Diabetic retinopathy graded by the modified Davis classification · 45-degree field of view — 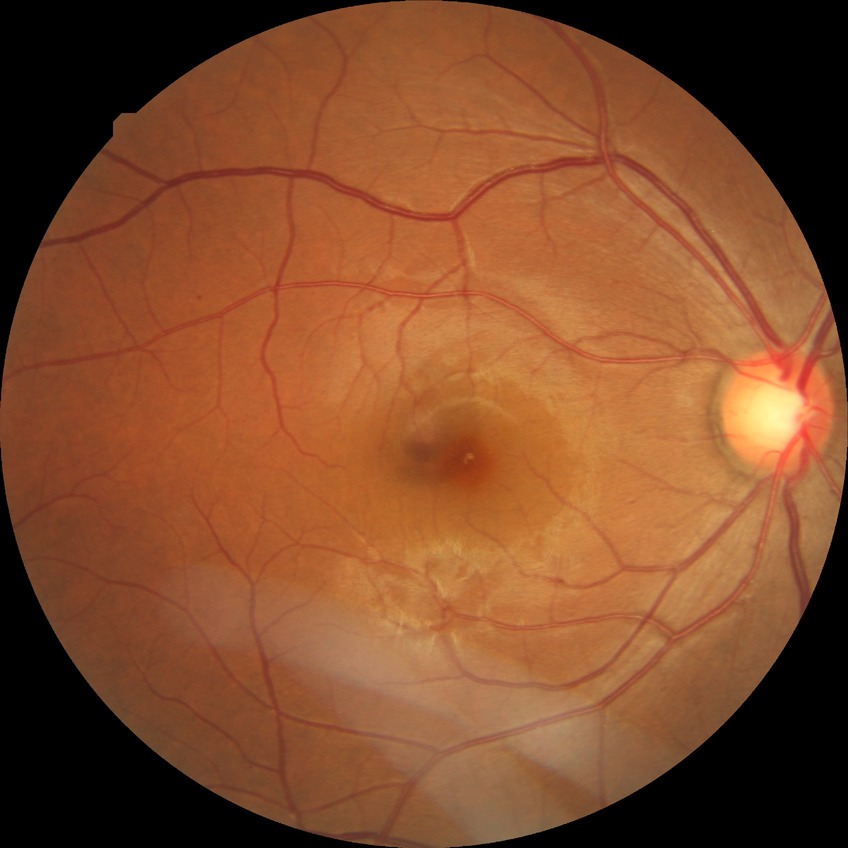

diabetic retinopathy (DR): NDR (no diabetic retinopathy).